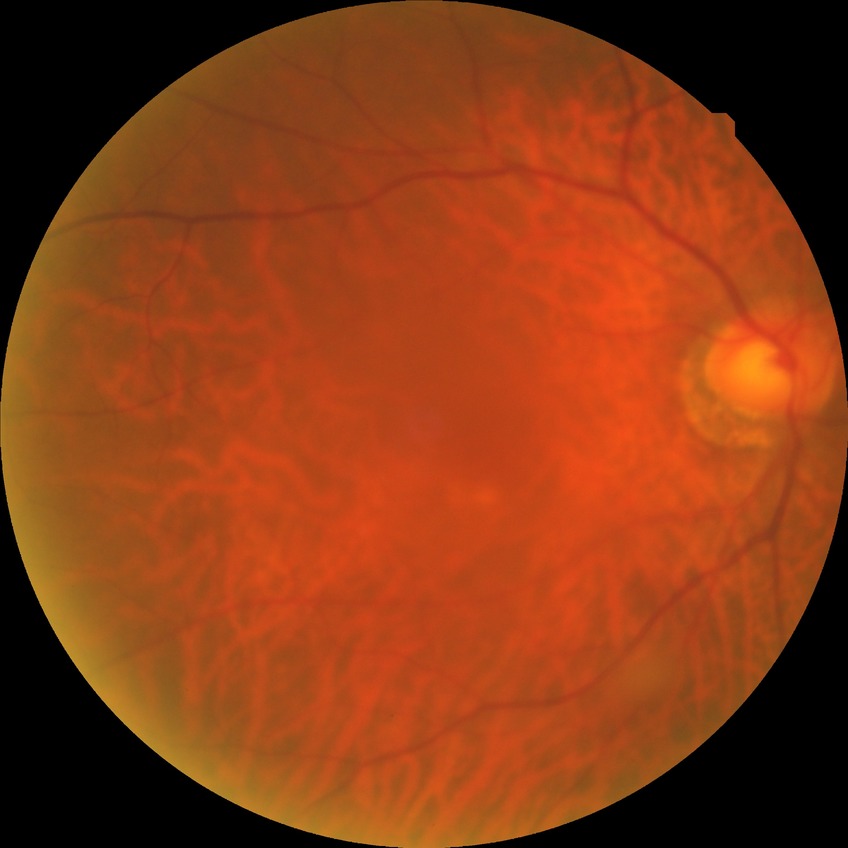

davis_grade: no diabetic retinopathy